Acquired with a Topcon TRC-NW8, 1932x1932, FOV: 50 degrees — 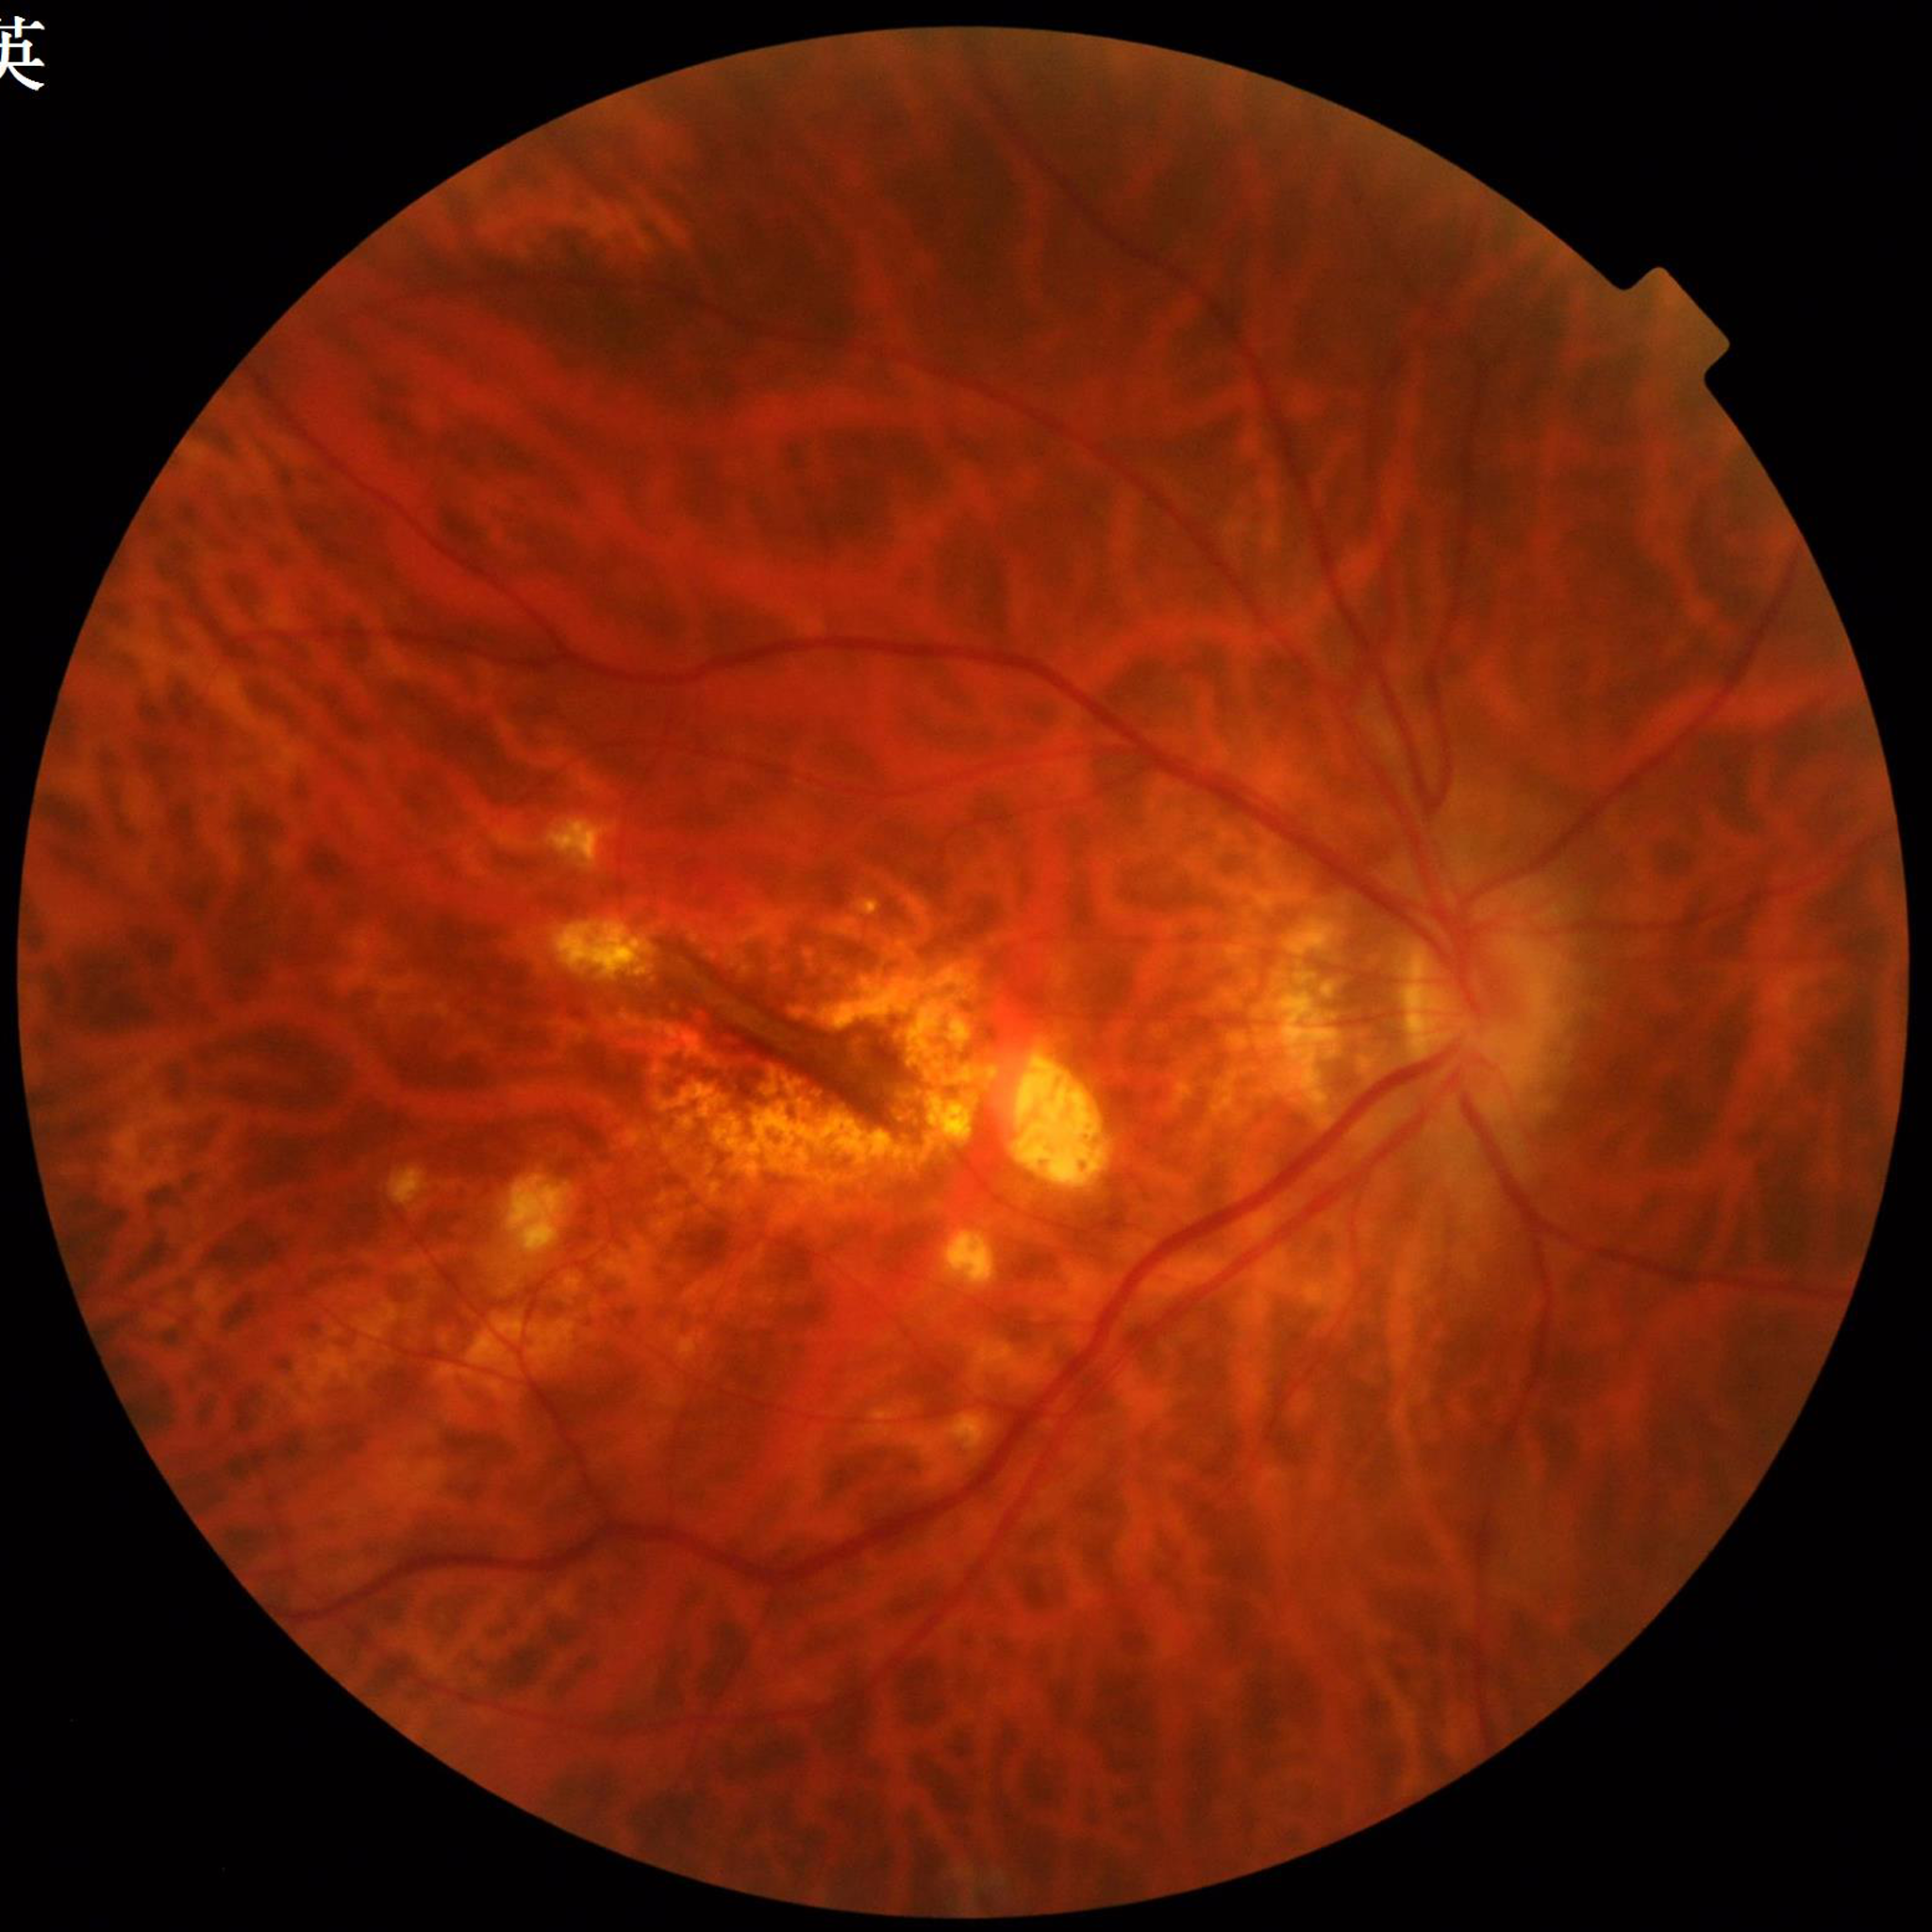
From a patient with AMD.